848x848px: 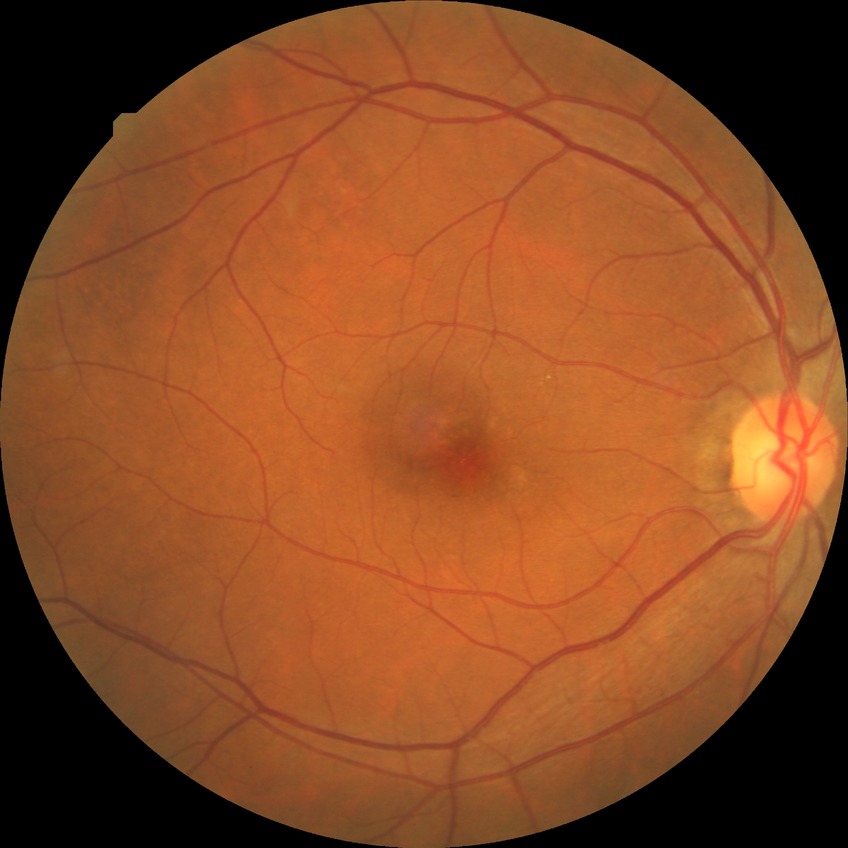 No diabetic retinal disease findings. DR severity: NDR.